Color fundus image, 45° FOV — 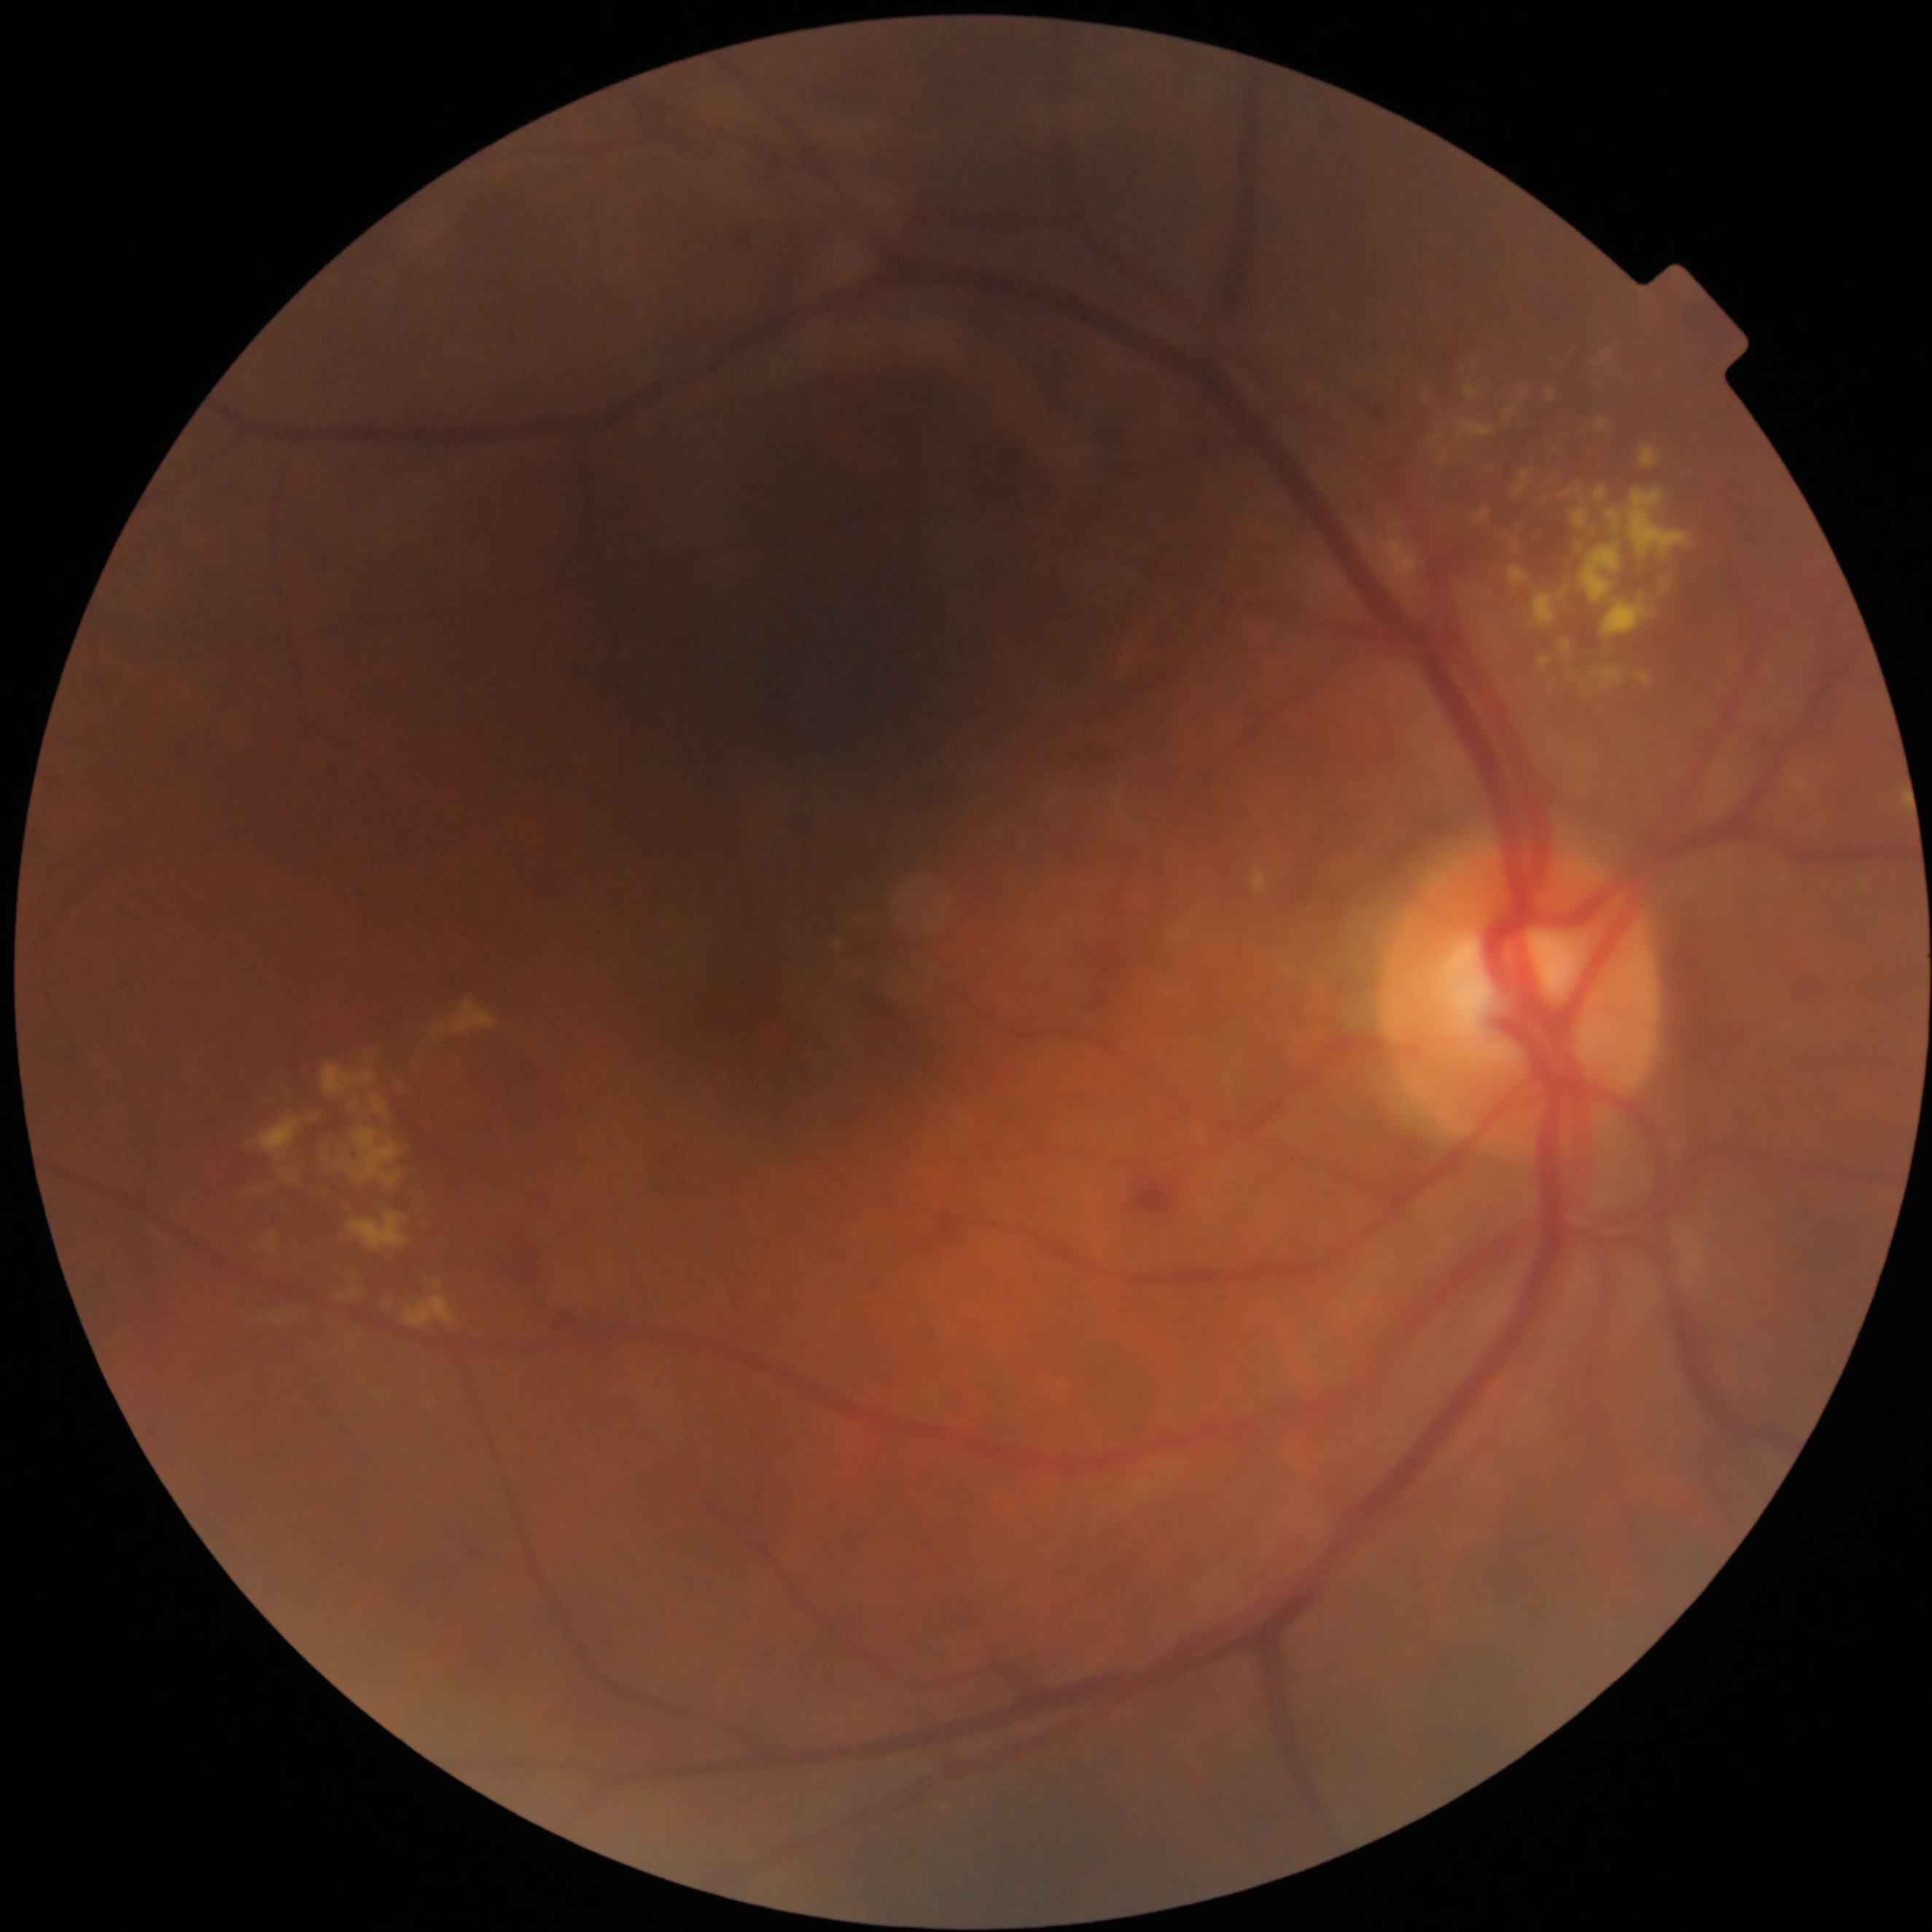
{"dr_category": "non-proliferative diabetic retinopathy", "dr_grade": "moderate non-proliferative diabetic retinopathy (grade 2)"}